Retinal fundus photograph.
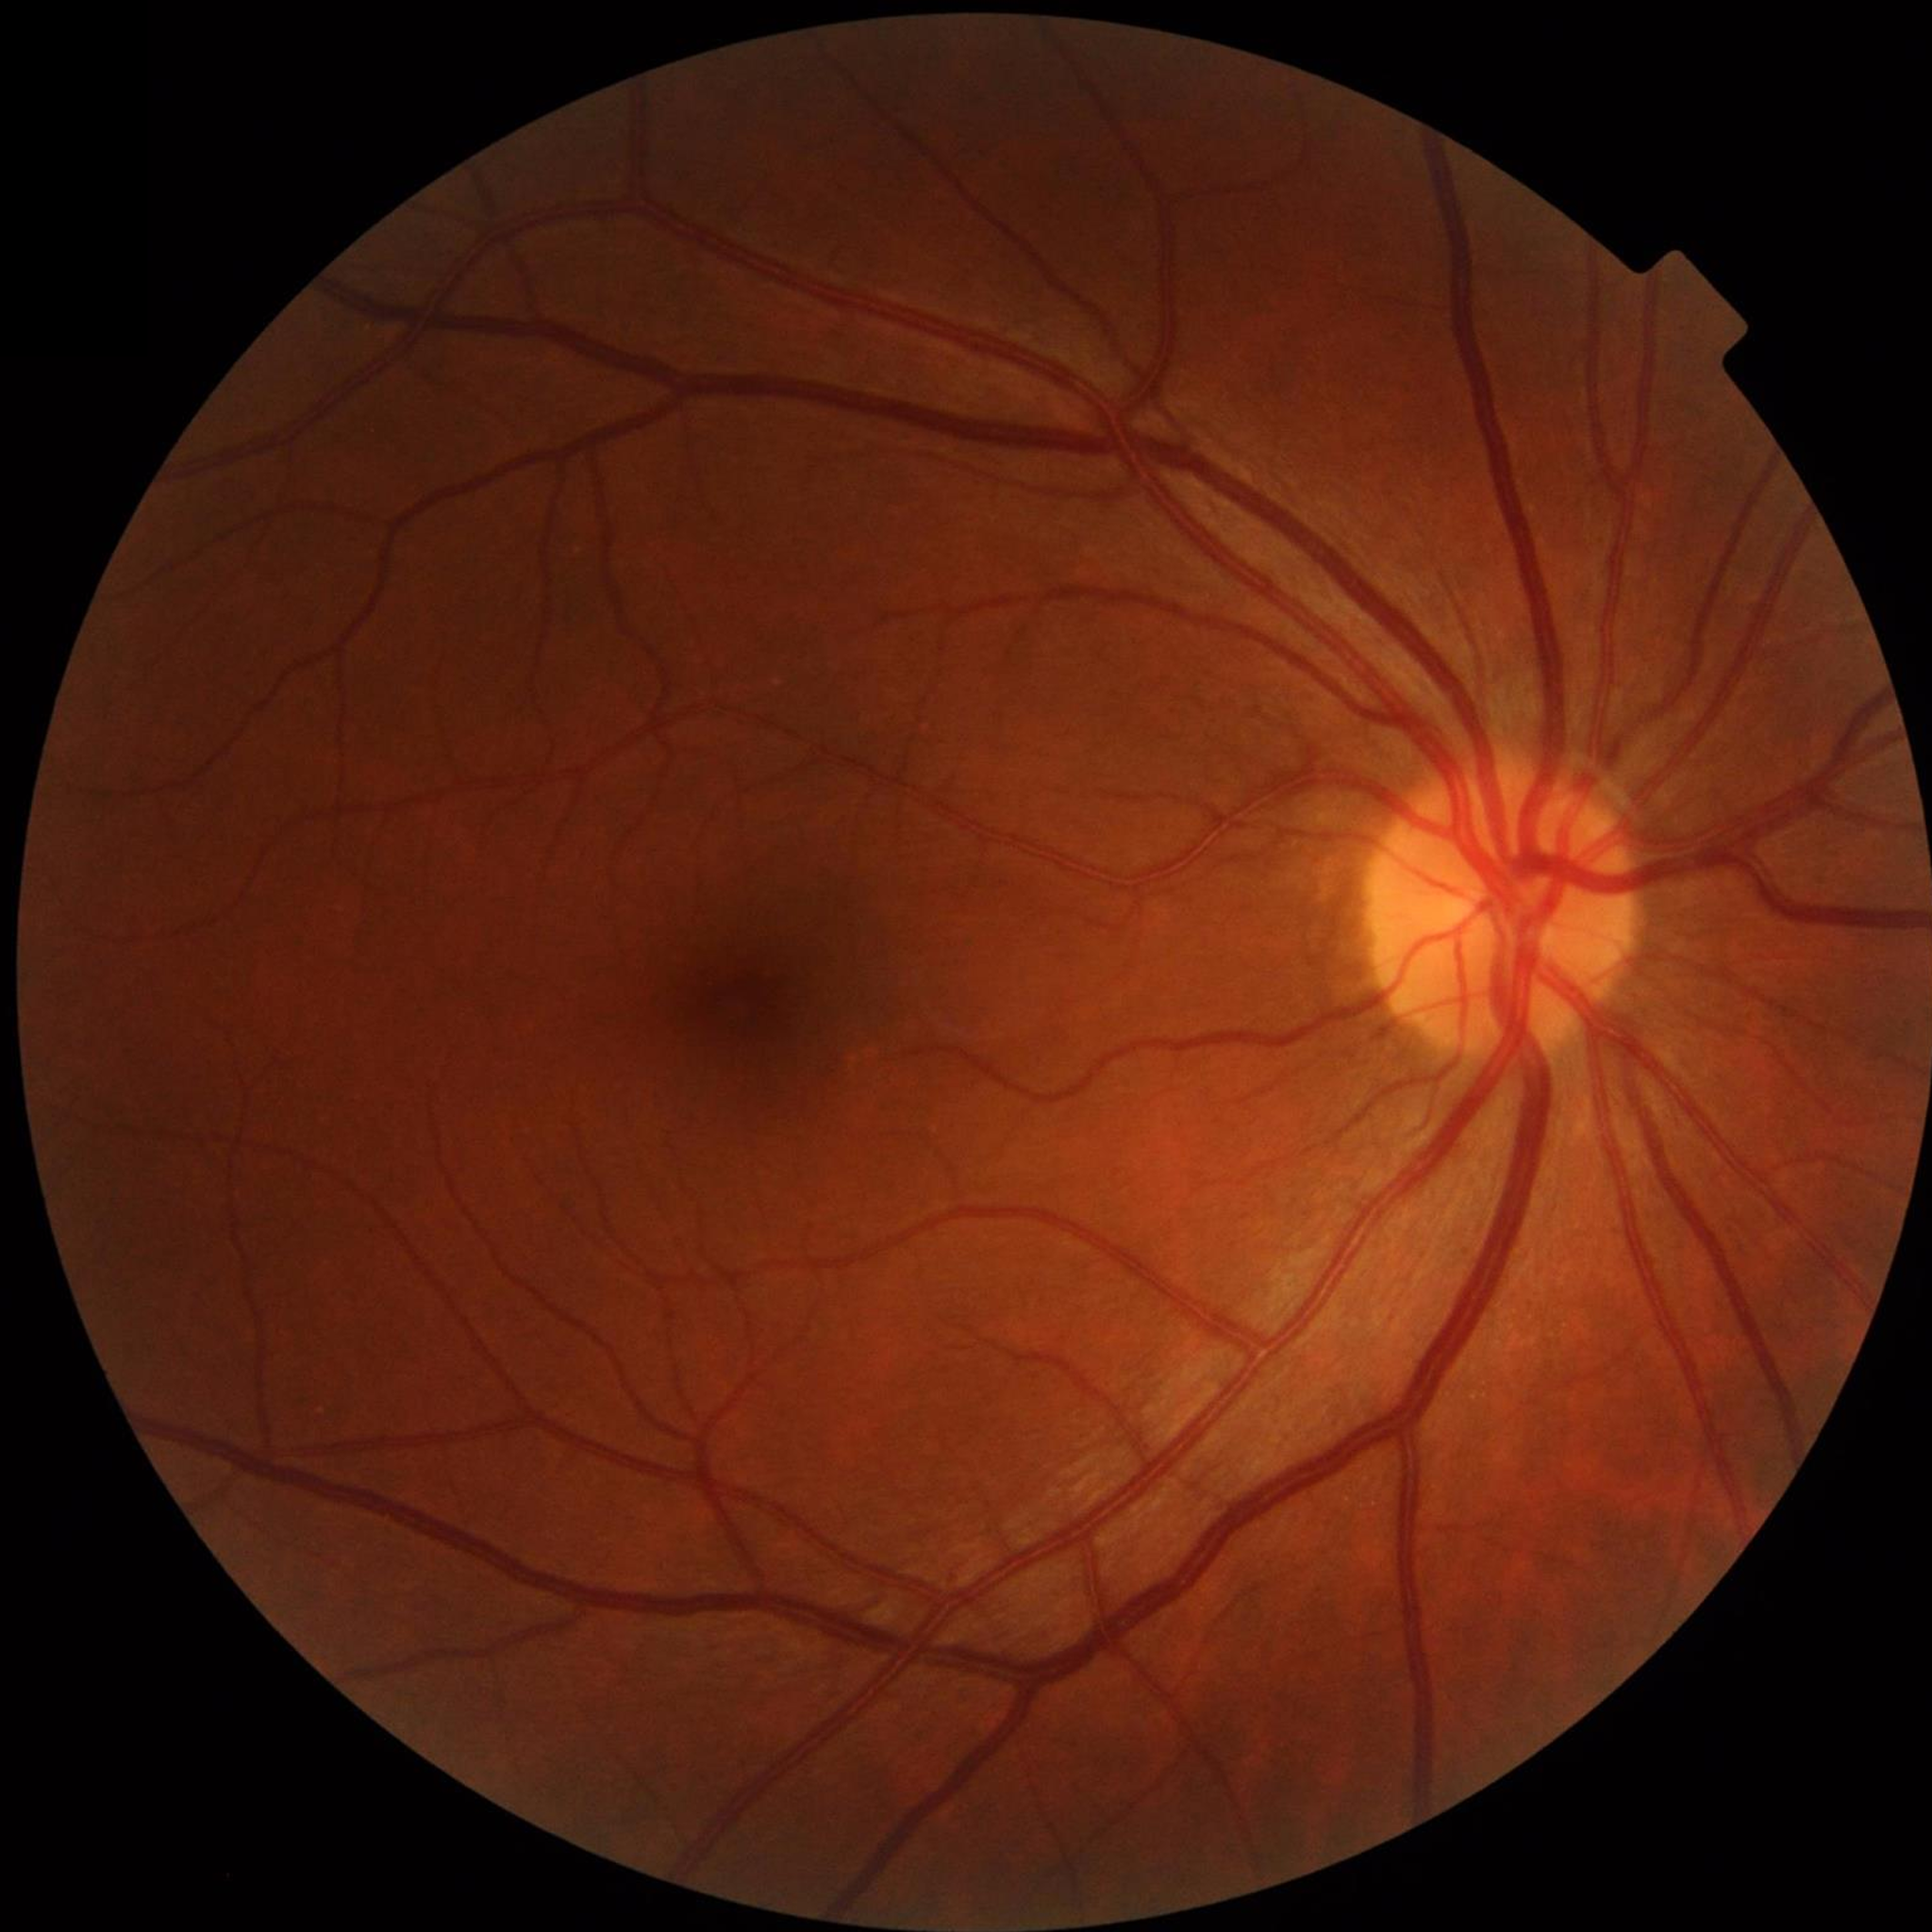 Condition = no AMD, DR, or glaucoma.